1240 by 1240 pixels; wide-field contact fundus photograph of an infant.
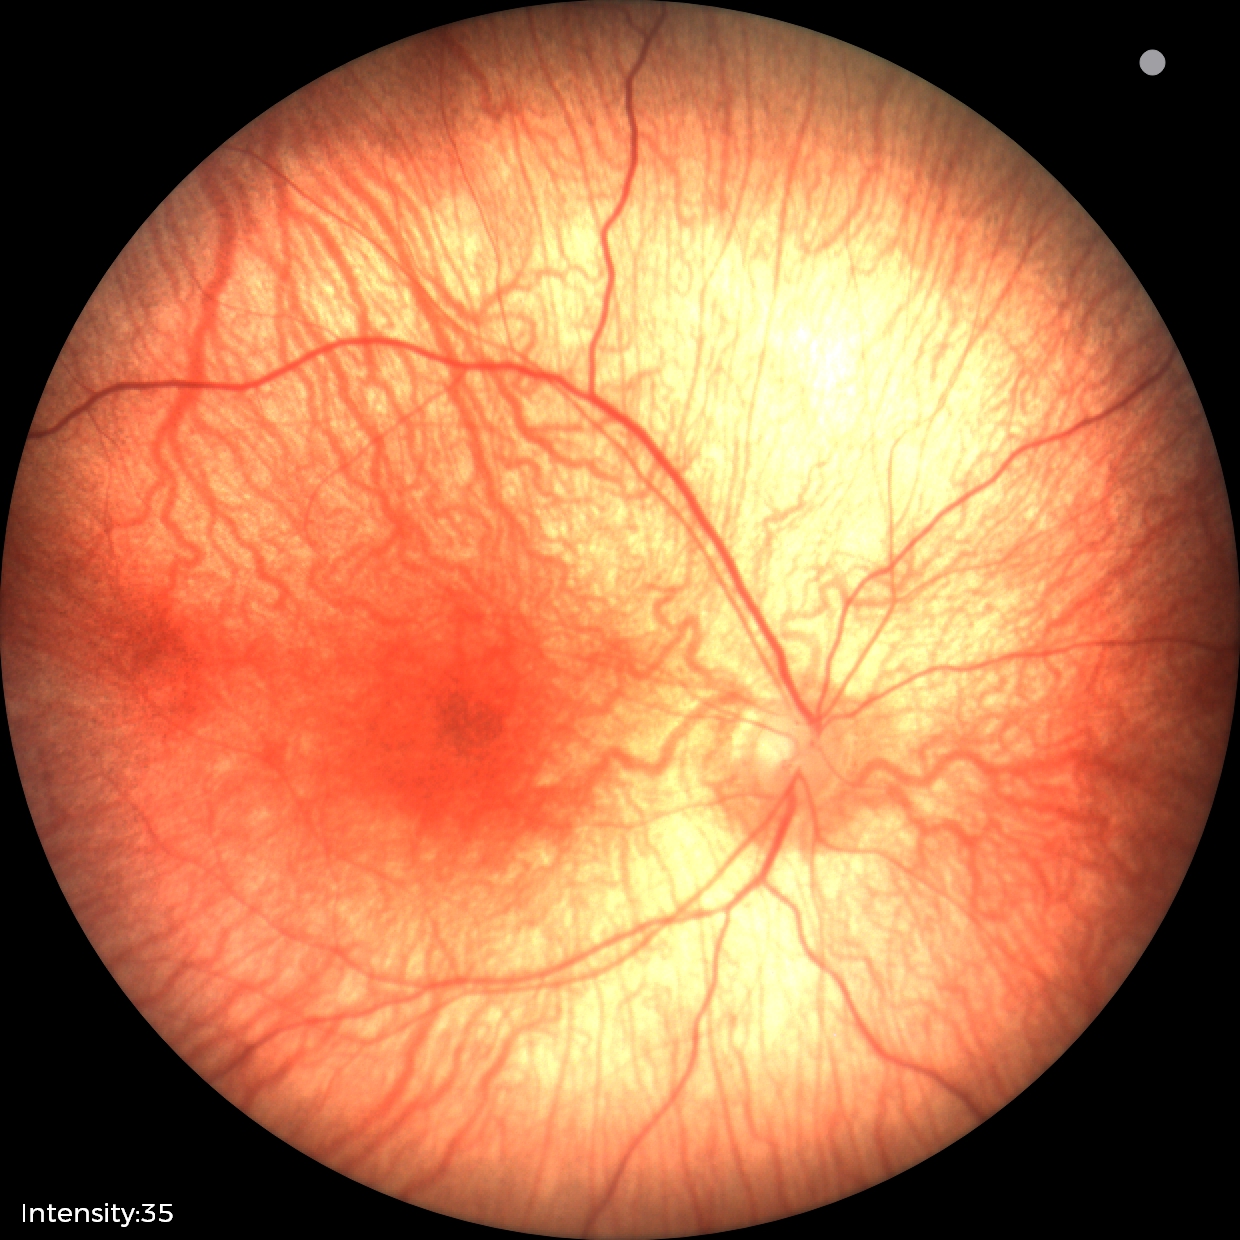

Screening examination with no abnormal retinal findings.